Clarity RetCam 3, 130° FOV; wide-field contact fundus photograph of an infant:
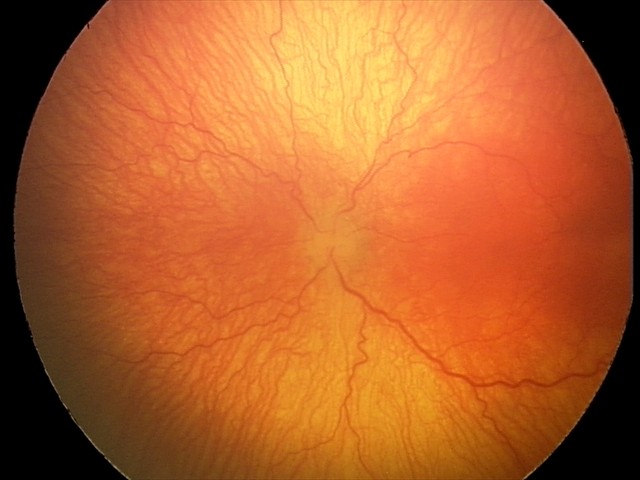

Screening: aggressive ROP (A-ROP); plus disease.